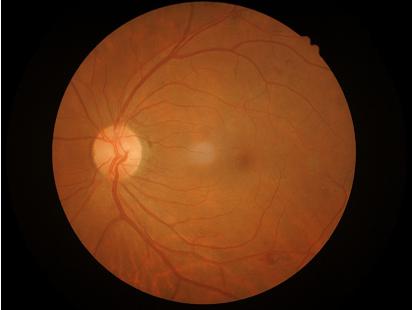

Illumination and color balance are good.
Image is sharp throughout the field.
Overall image quality is good.